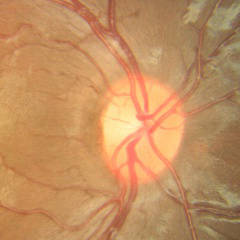 No signs of glaucoma.